Phoenix ICON wide-field infant fundus image: 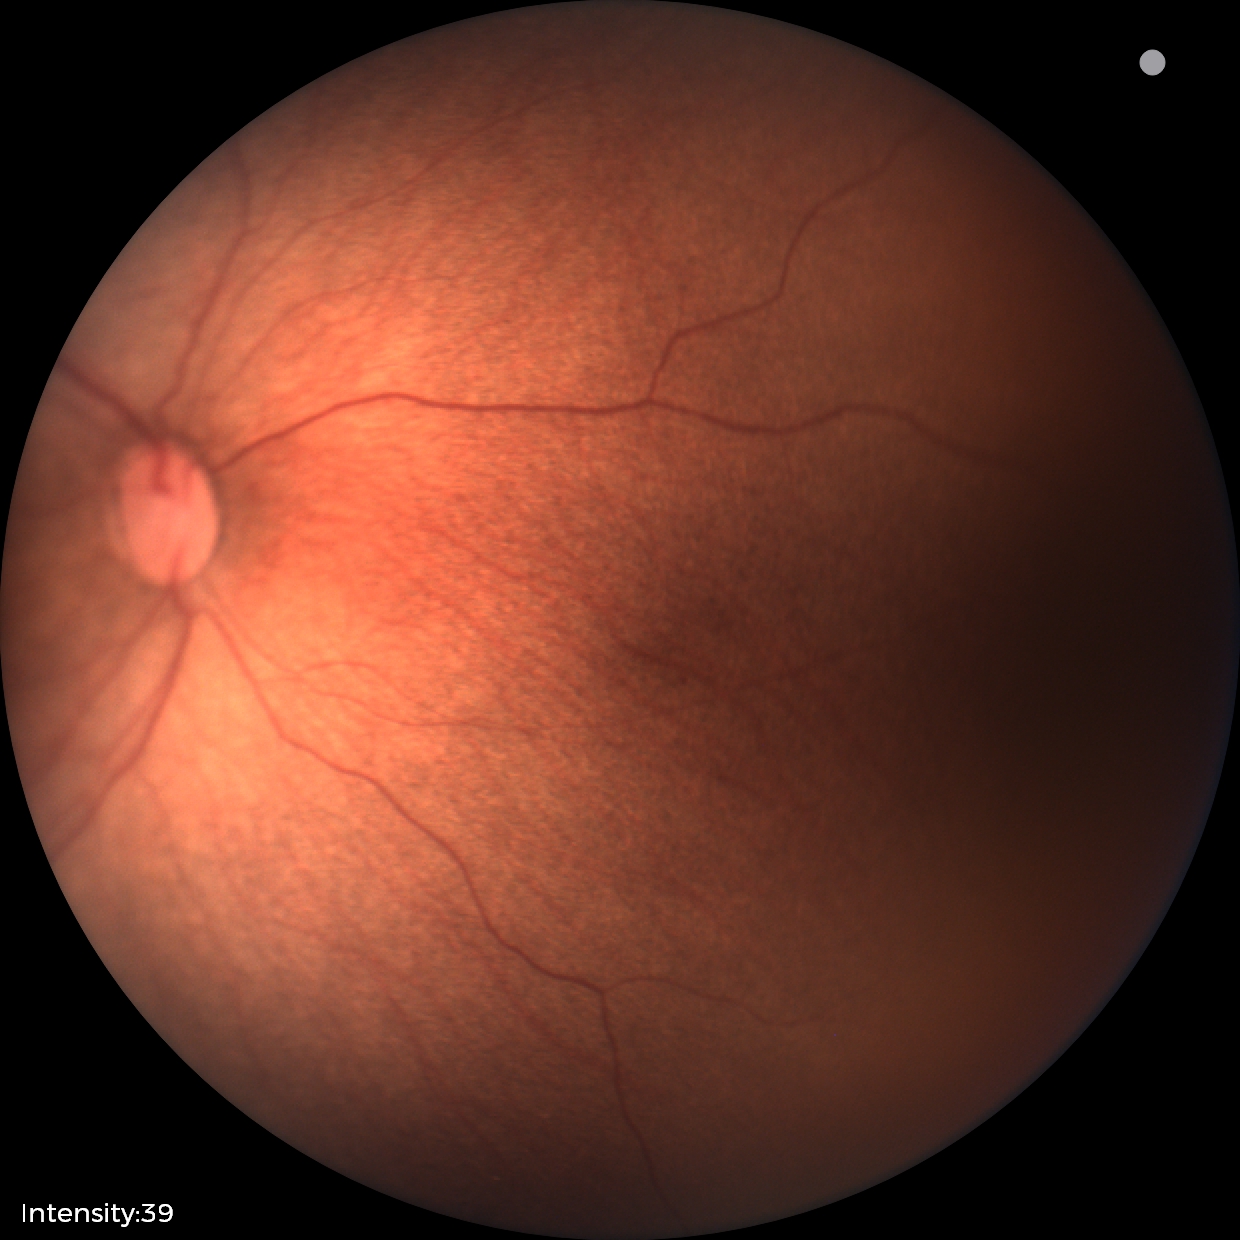

Q: Is plus disease present?
A: no plus disease — posterior pole vessels without abnormal dilation or tortuosity
Q: What was the screening finding?
A: status post ROP